2089 x 1764 pixels: 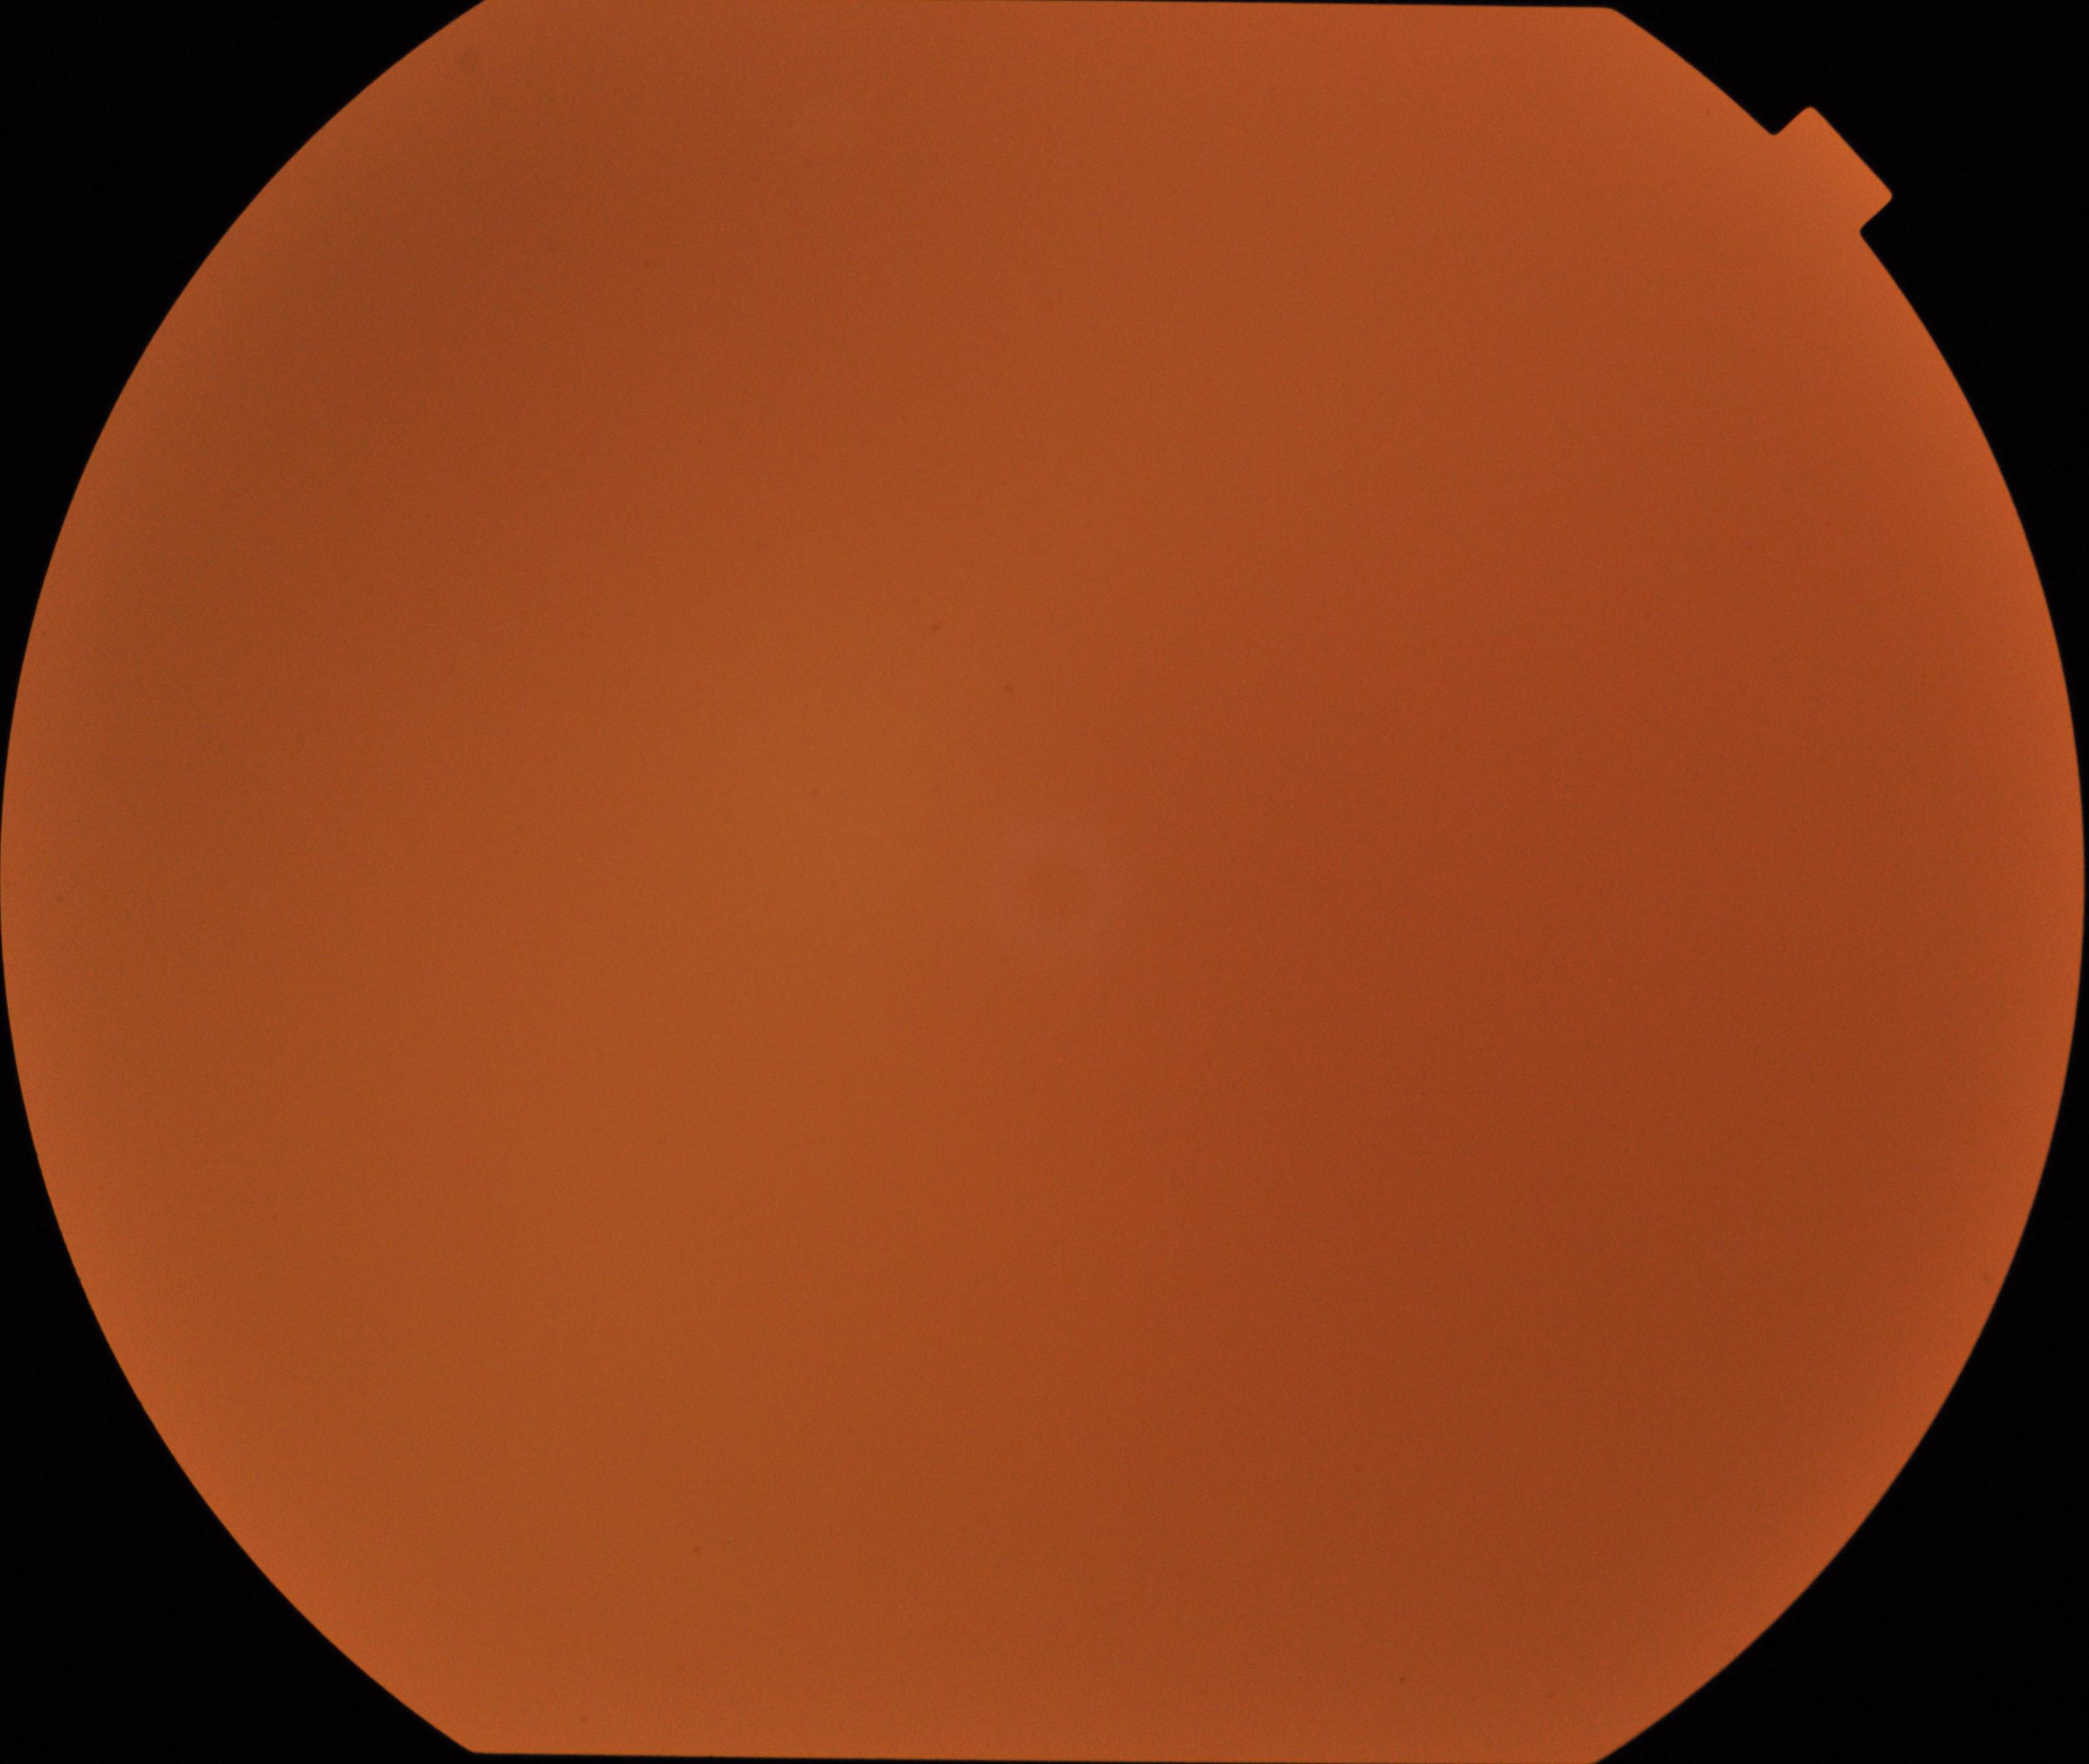
Image quality: poor, substantial obscuration of retinal landmarks.
Proliferative diabetic retinopathy: absent.